Optic disc-centered crop. Nidek AFC-330. Non-mydriatic acquisition — 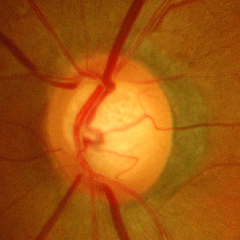

Glaucoma status: advanced glaucoma.